Color fundus image · optic disc-centered crop.
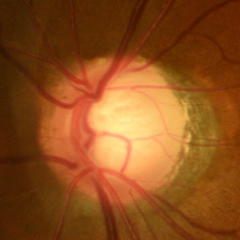 Impression: early-stage glaucoma.